FOV: 45 degrees
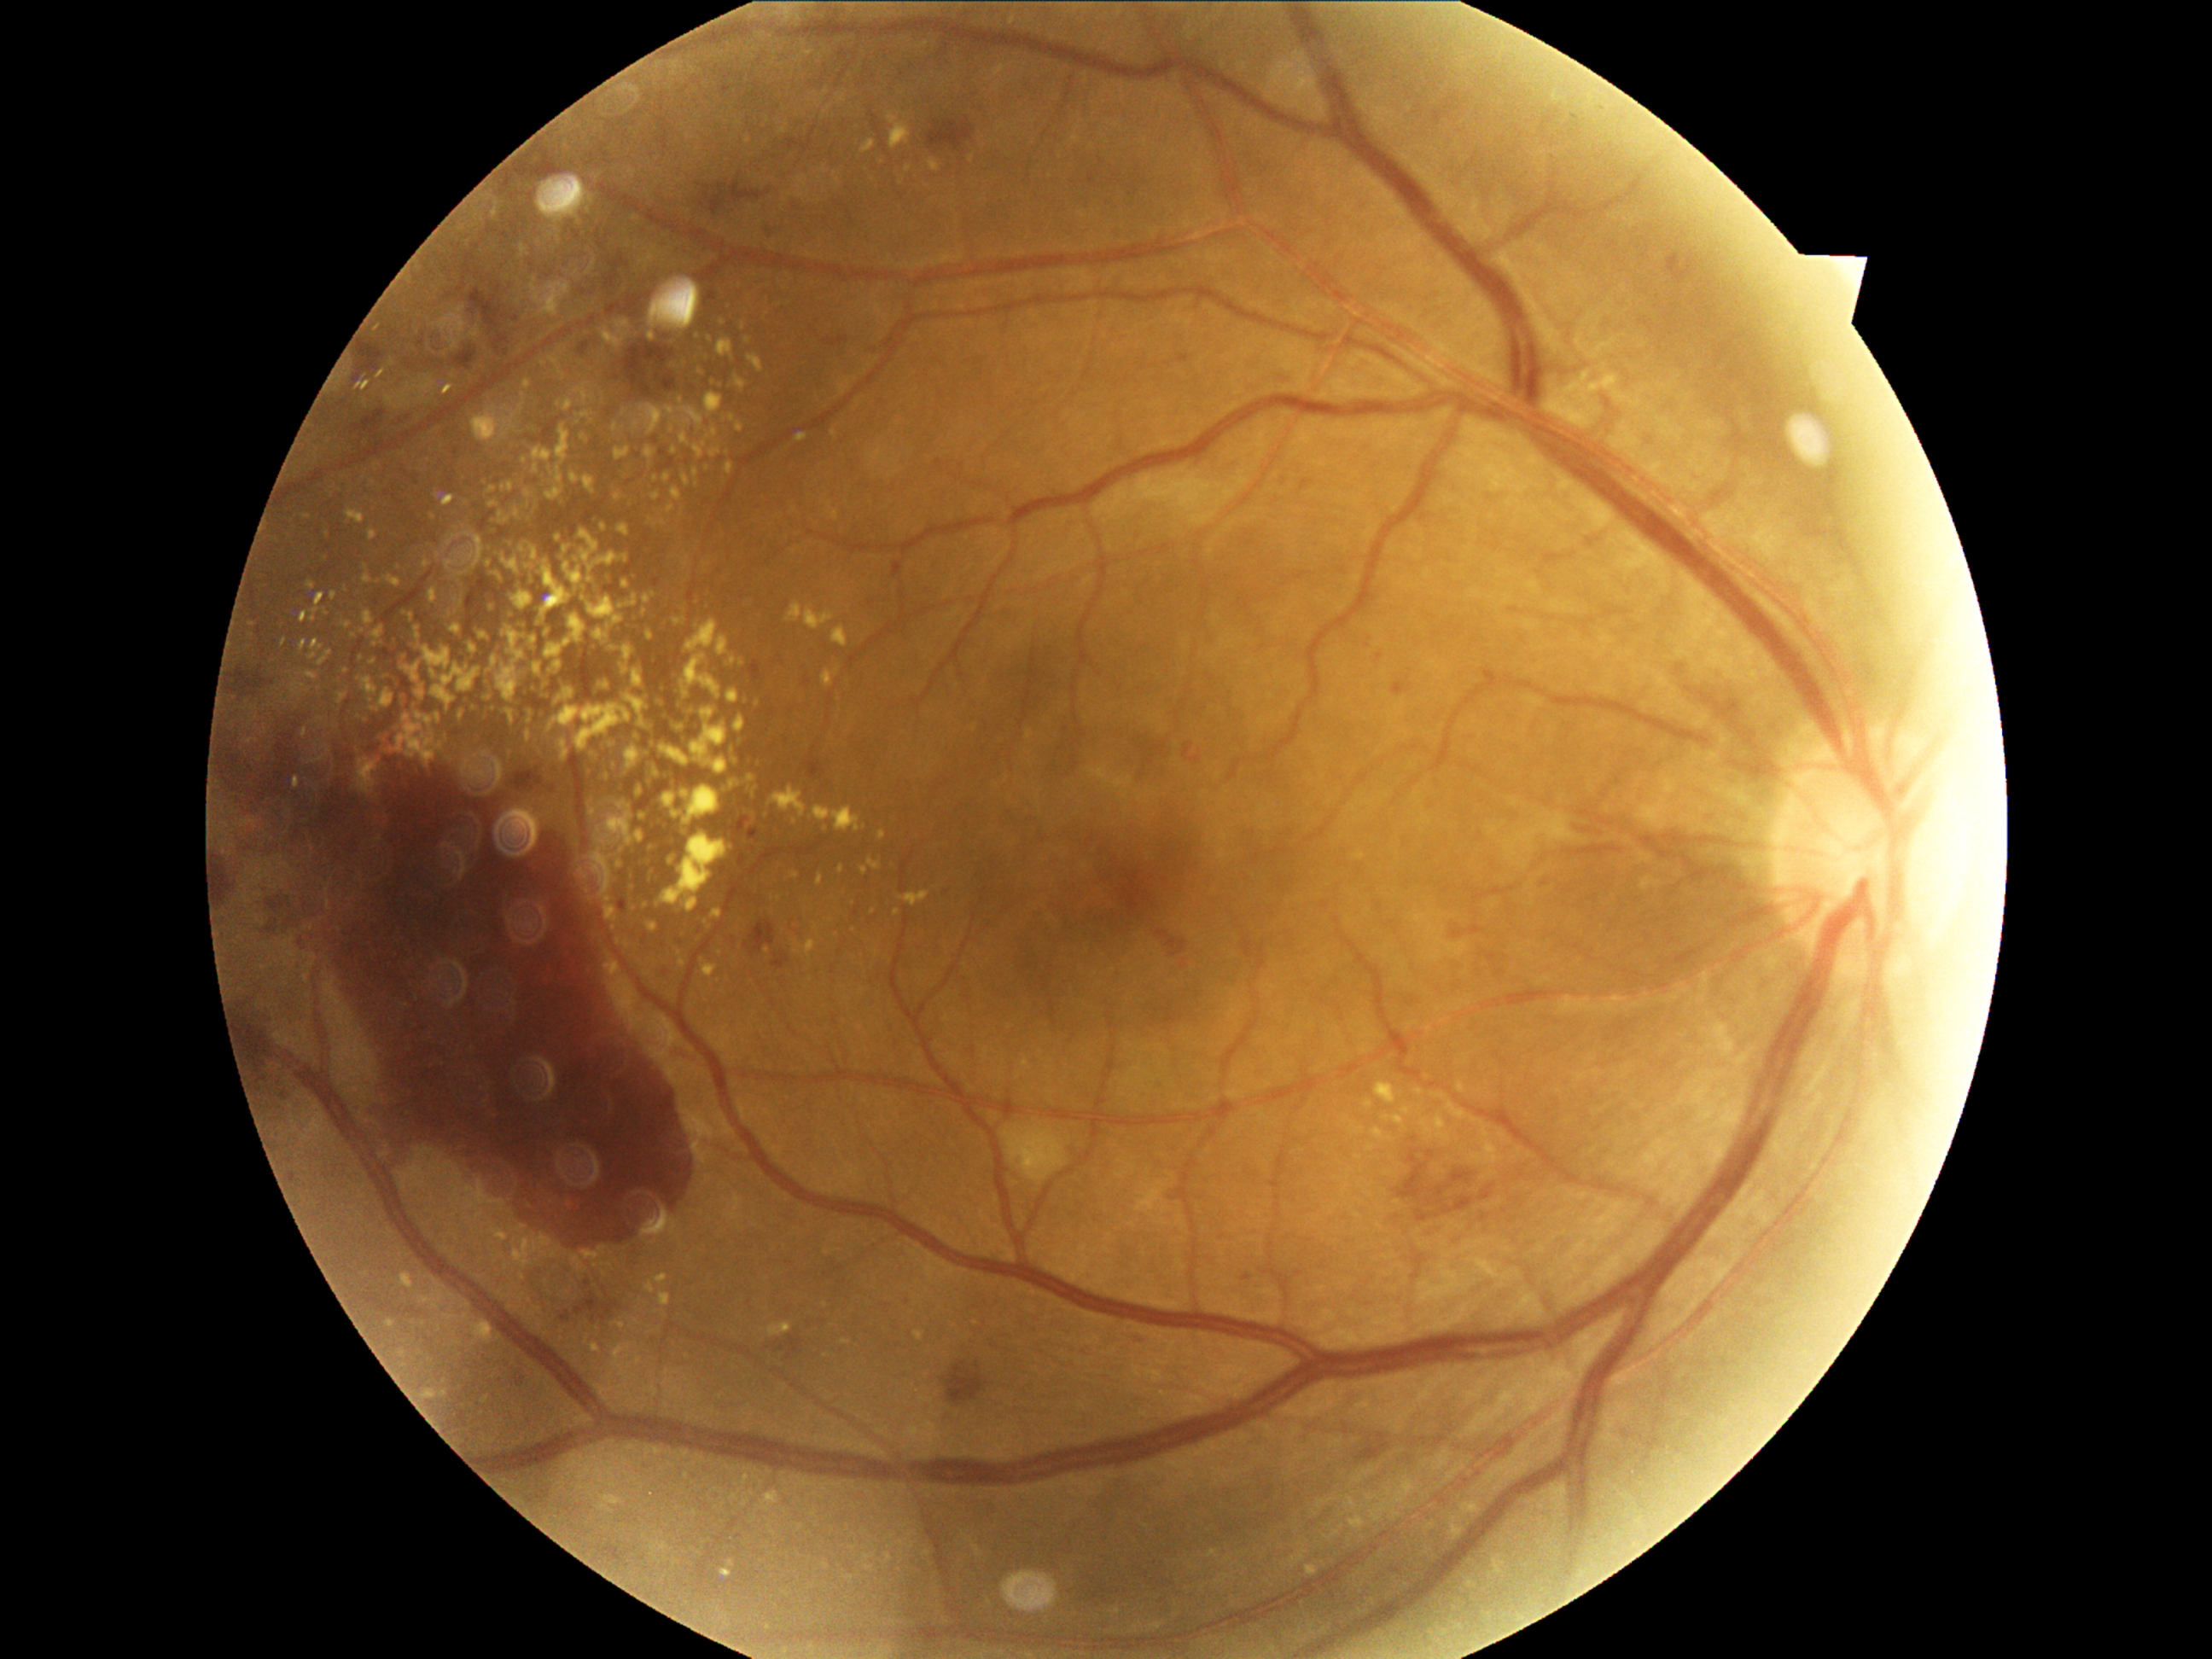

Diabetic retinopathy (DR): grade 4 (PDR)
Selected lesions:
hard exudates (EXs) (partial) = l=1482, t=1129, r=1487, b=1138 | l=387, t=576, r=402, b=588 | l=641, t=861, r=644, b=870 | l=364, t=612, r=375, b=626 | l=509, t=593, r=533, b=610 | l=682, t=791, r=690, b=798 | l=651, t=765, r=660, b=776 | l=301, t=612, r=308, b=622 | l=627, t=597, r=637, b=607 | l=631, t=571, r=636, b=583 | l=380, t=690, r=393, b=709 | l=607, t=813, r=634, b=846
Small EXs near point(799, 18) | point(412, 617) | point(842, 870) | point(489, 564) | point(633, 874) | point(682, 962) | point(919, 1335)